Fundus photo, 1659x2212, acquired with a Remidio FOP fundus camera
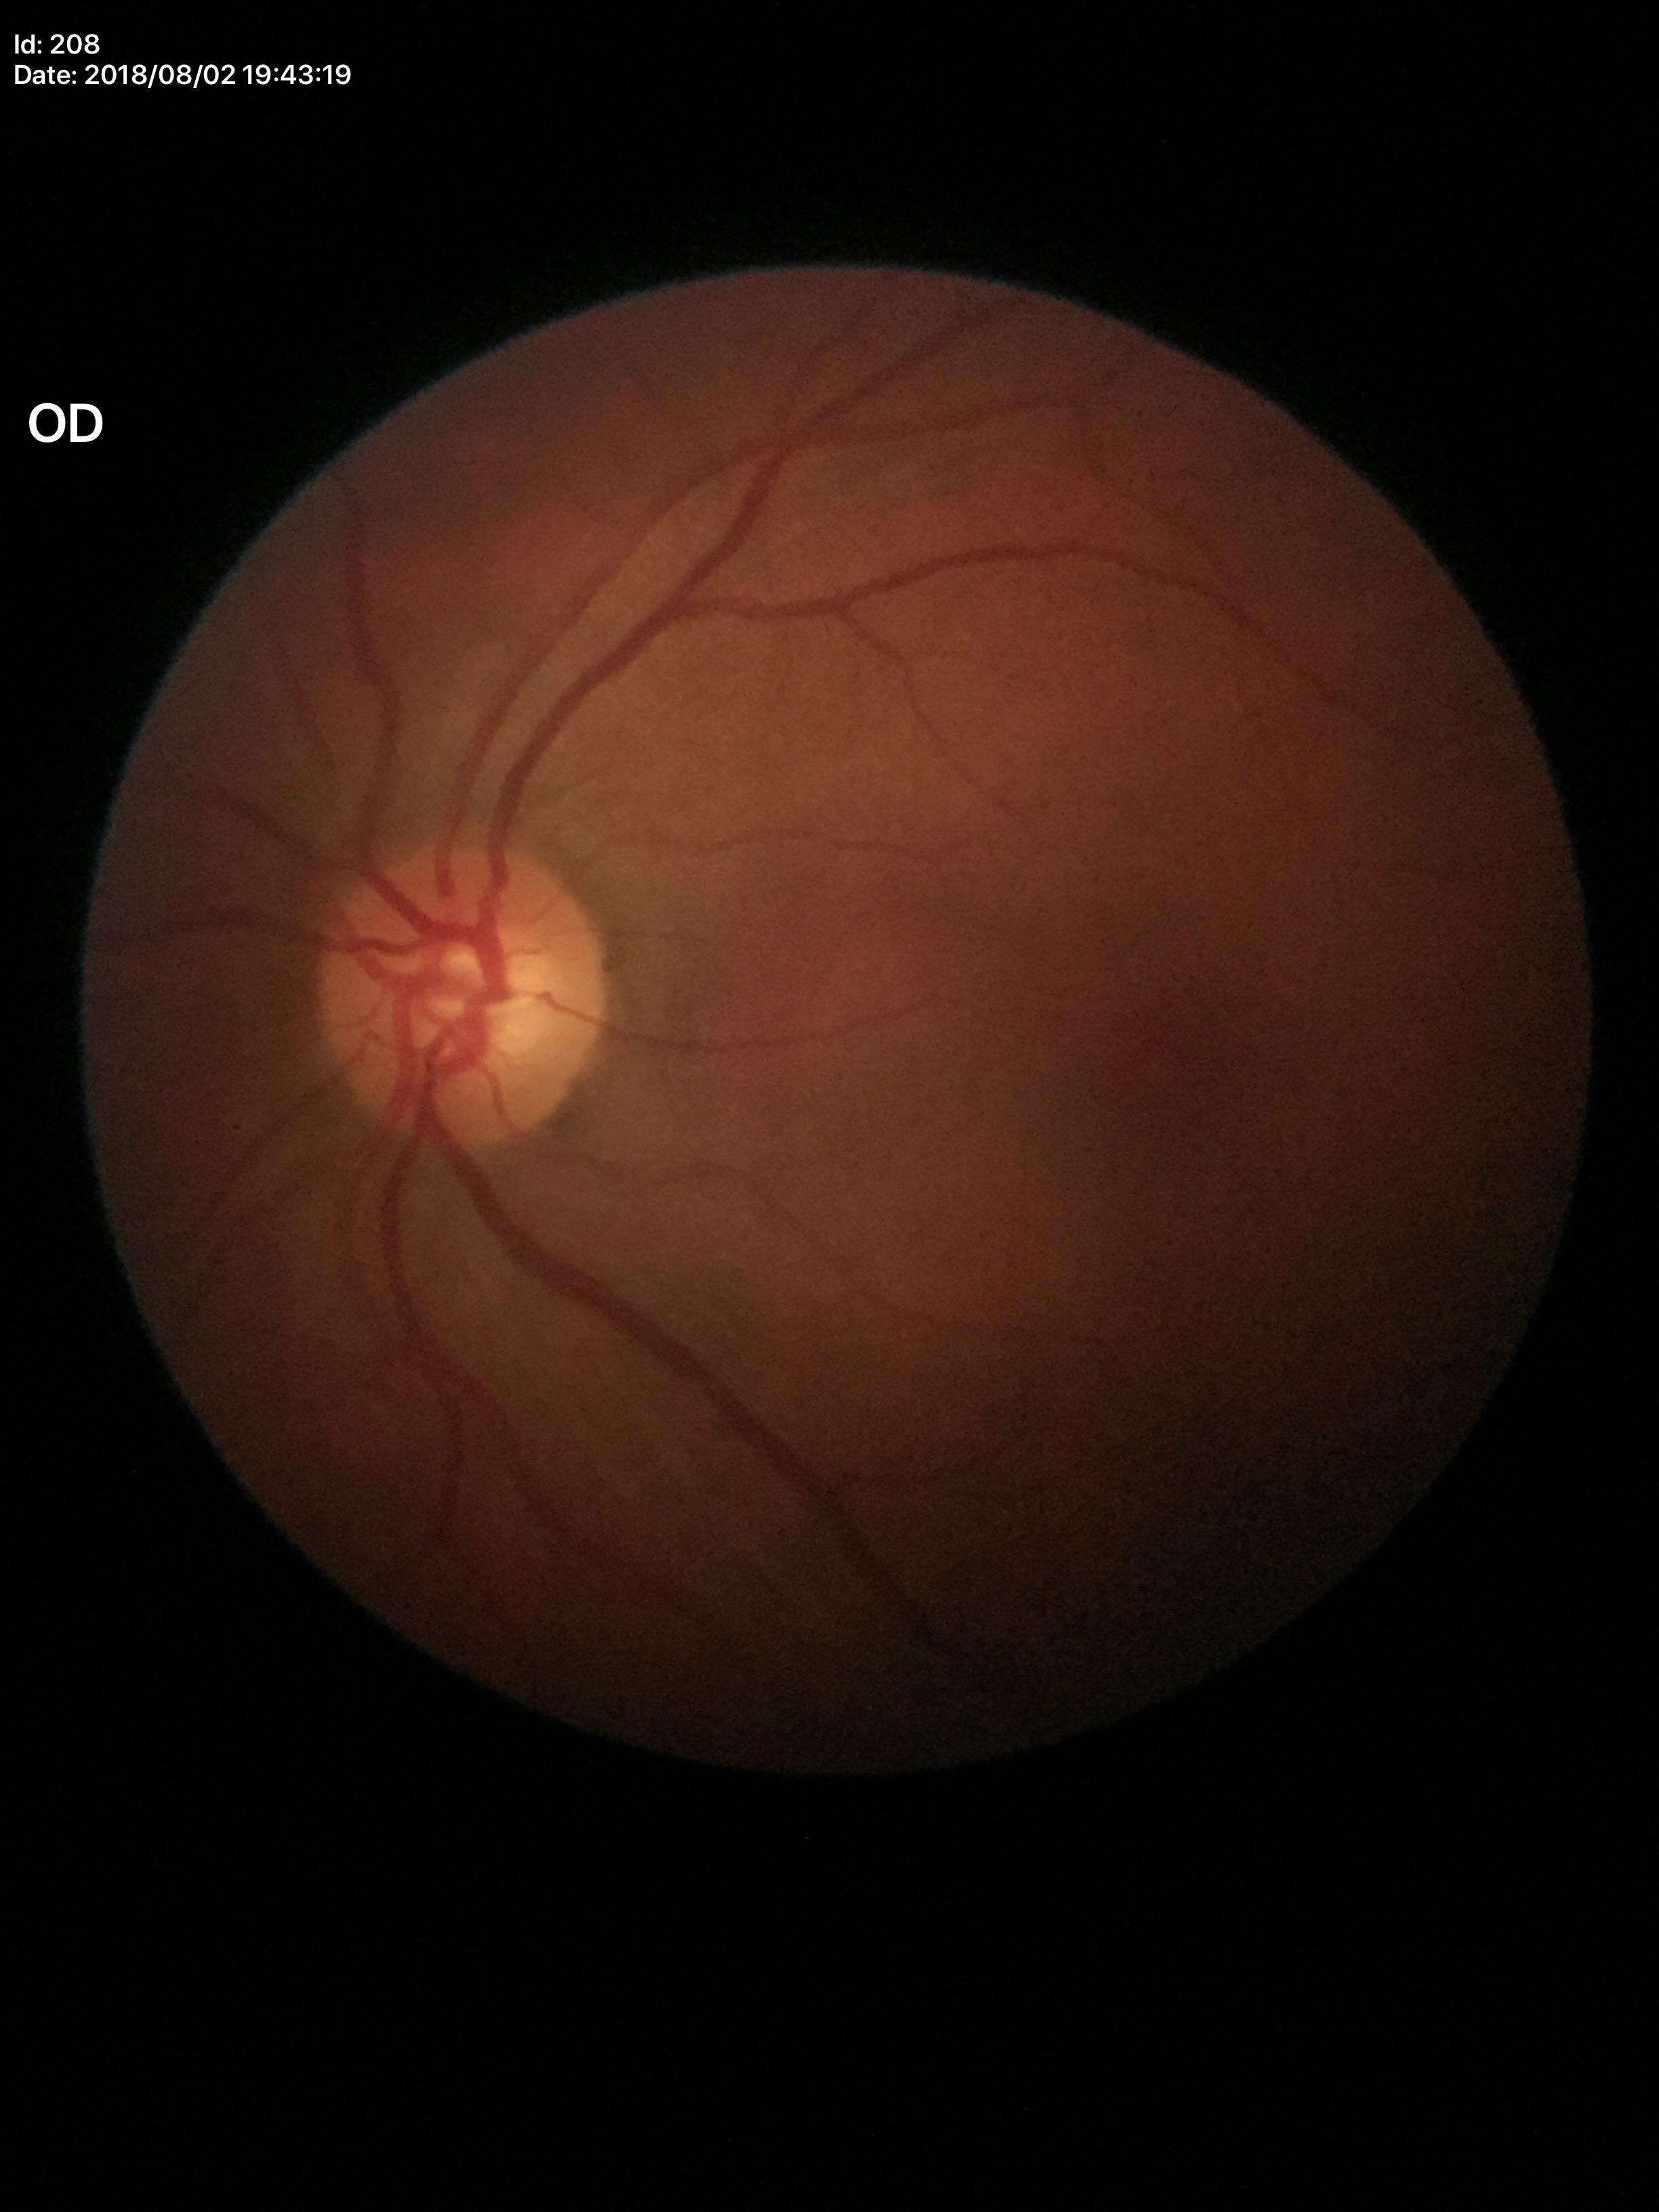
{
  "glaucoma_decision": "no suspicious findings",
  "vcdr": "0.55",
  "hcdr": "0.57",
  "acdr": "0.31"
}